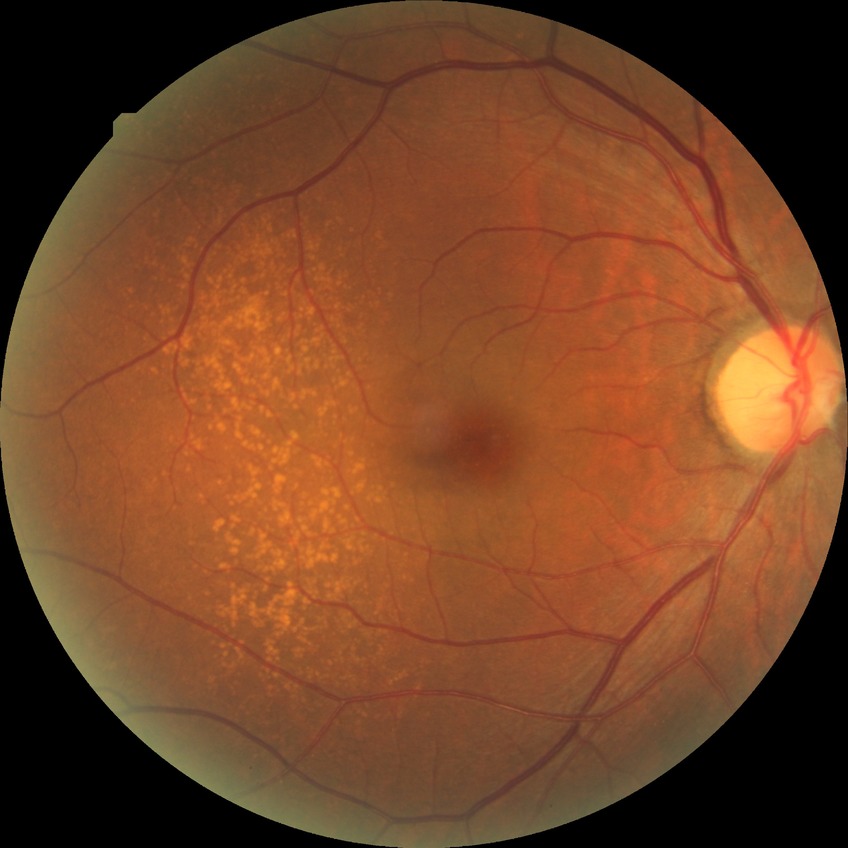 Retinopathy grade: no diabetic retinopathy.